Wide-field fundus photograph from neonatal ROP screening.
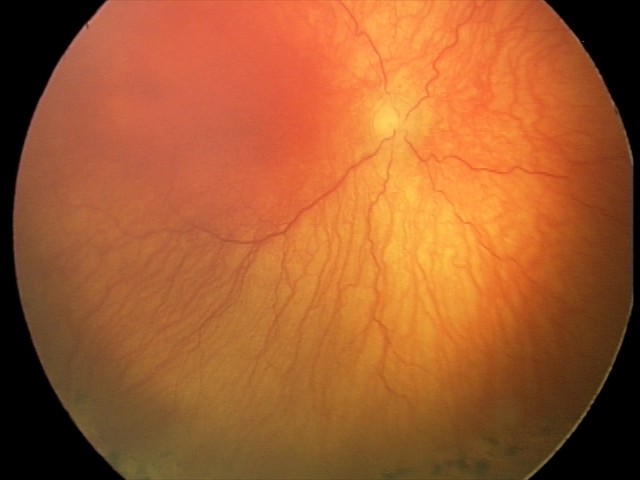

From an examination with diagnosis of aggressive retinopathy of prematurity.
Plus disease was diagnosed.